Posterior pole color fundus photograph · FOV: 45 degrees.
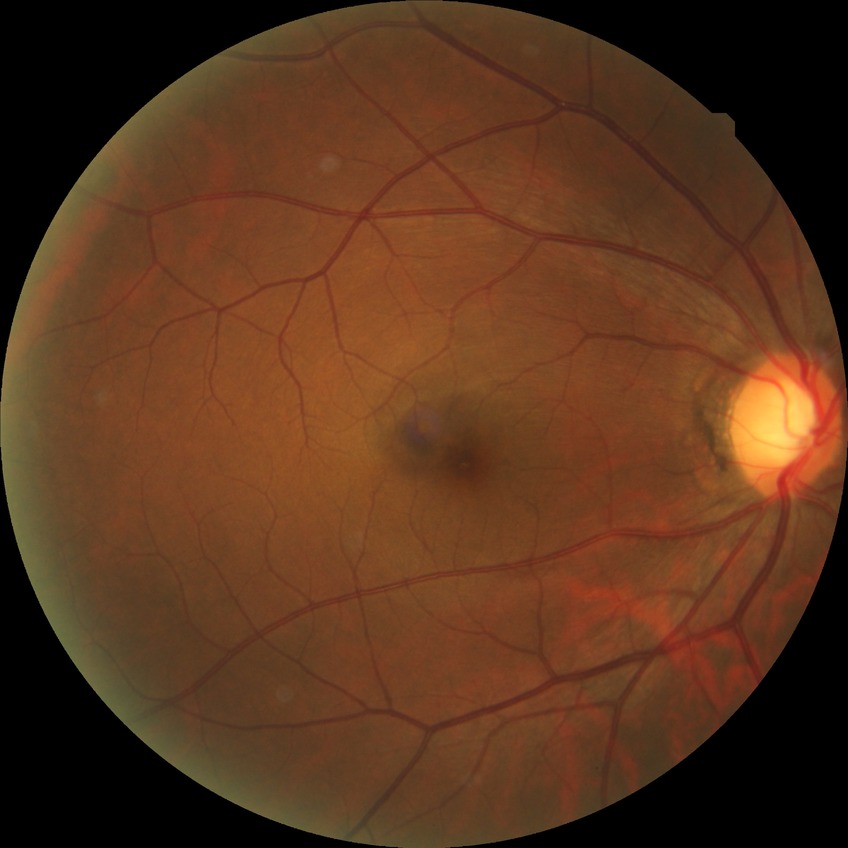
Diabetic retinopathy grade is no diabetic retinopathy.